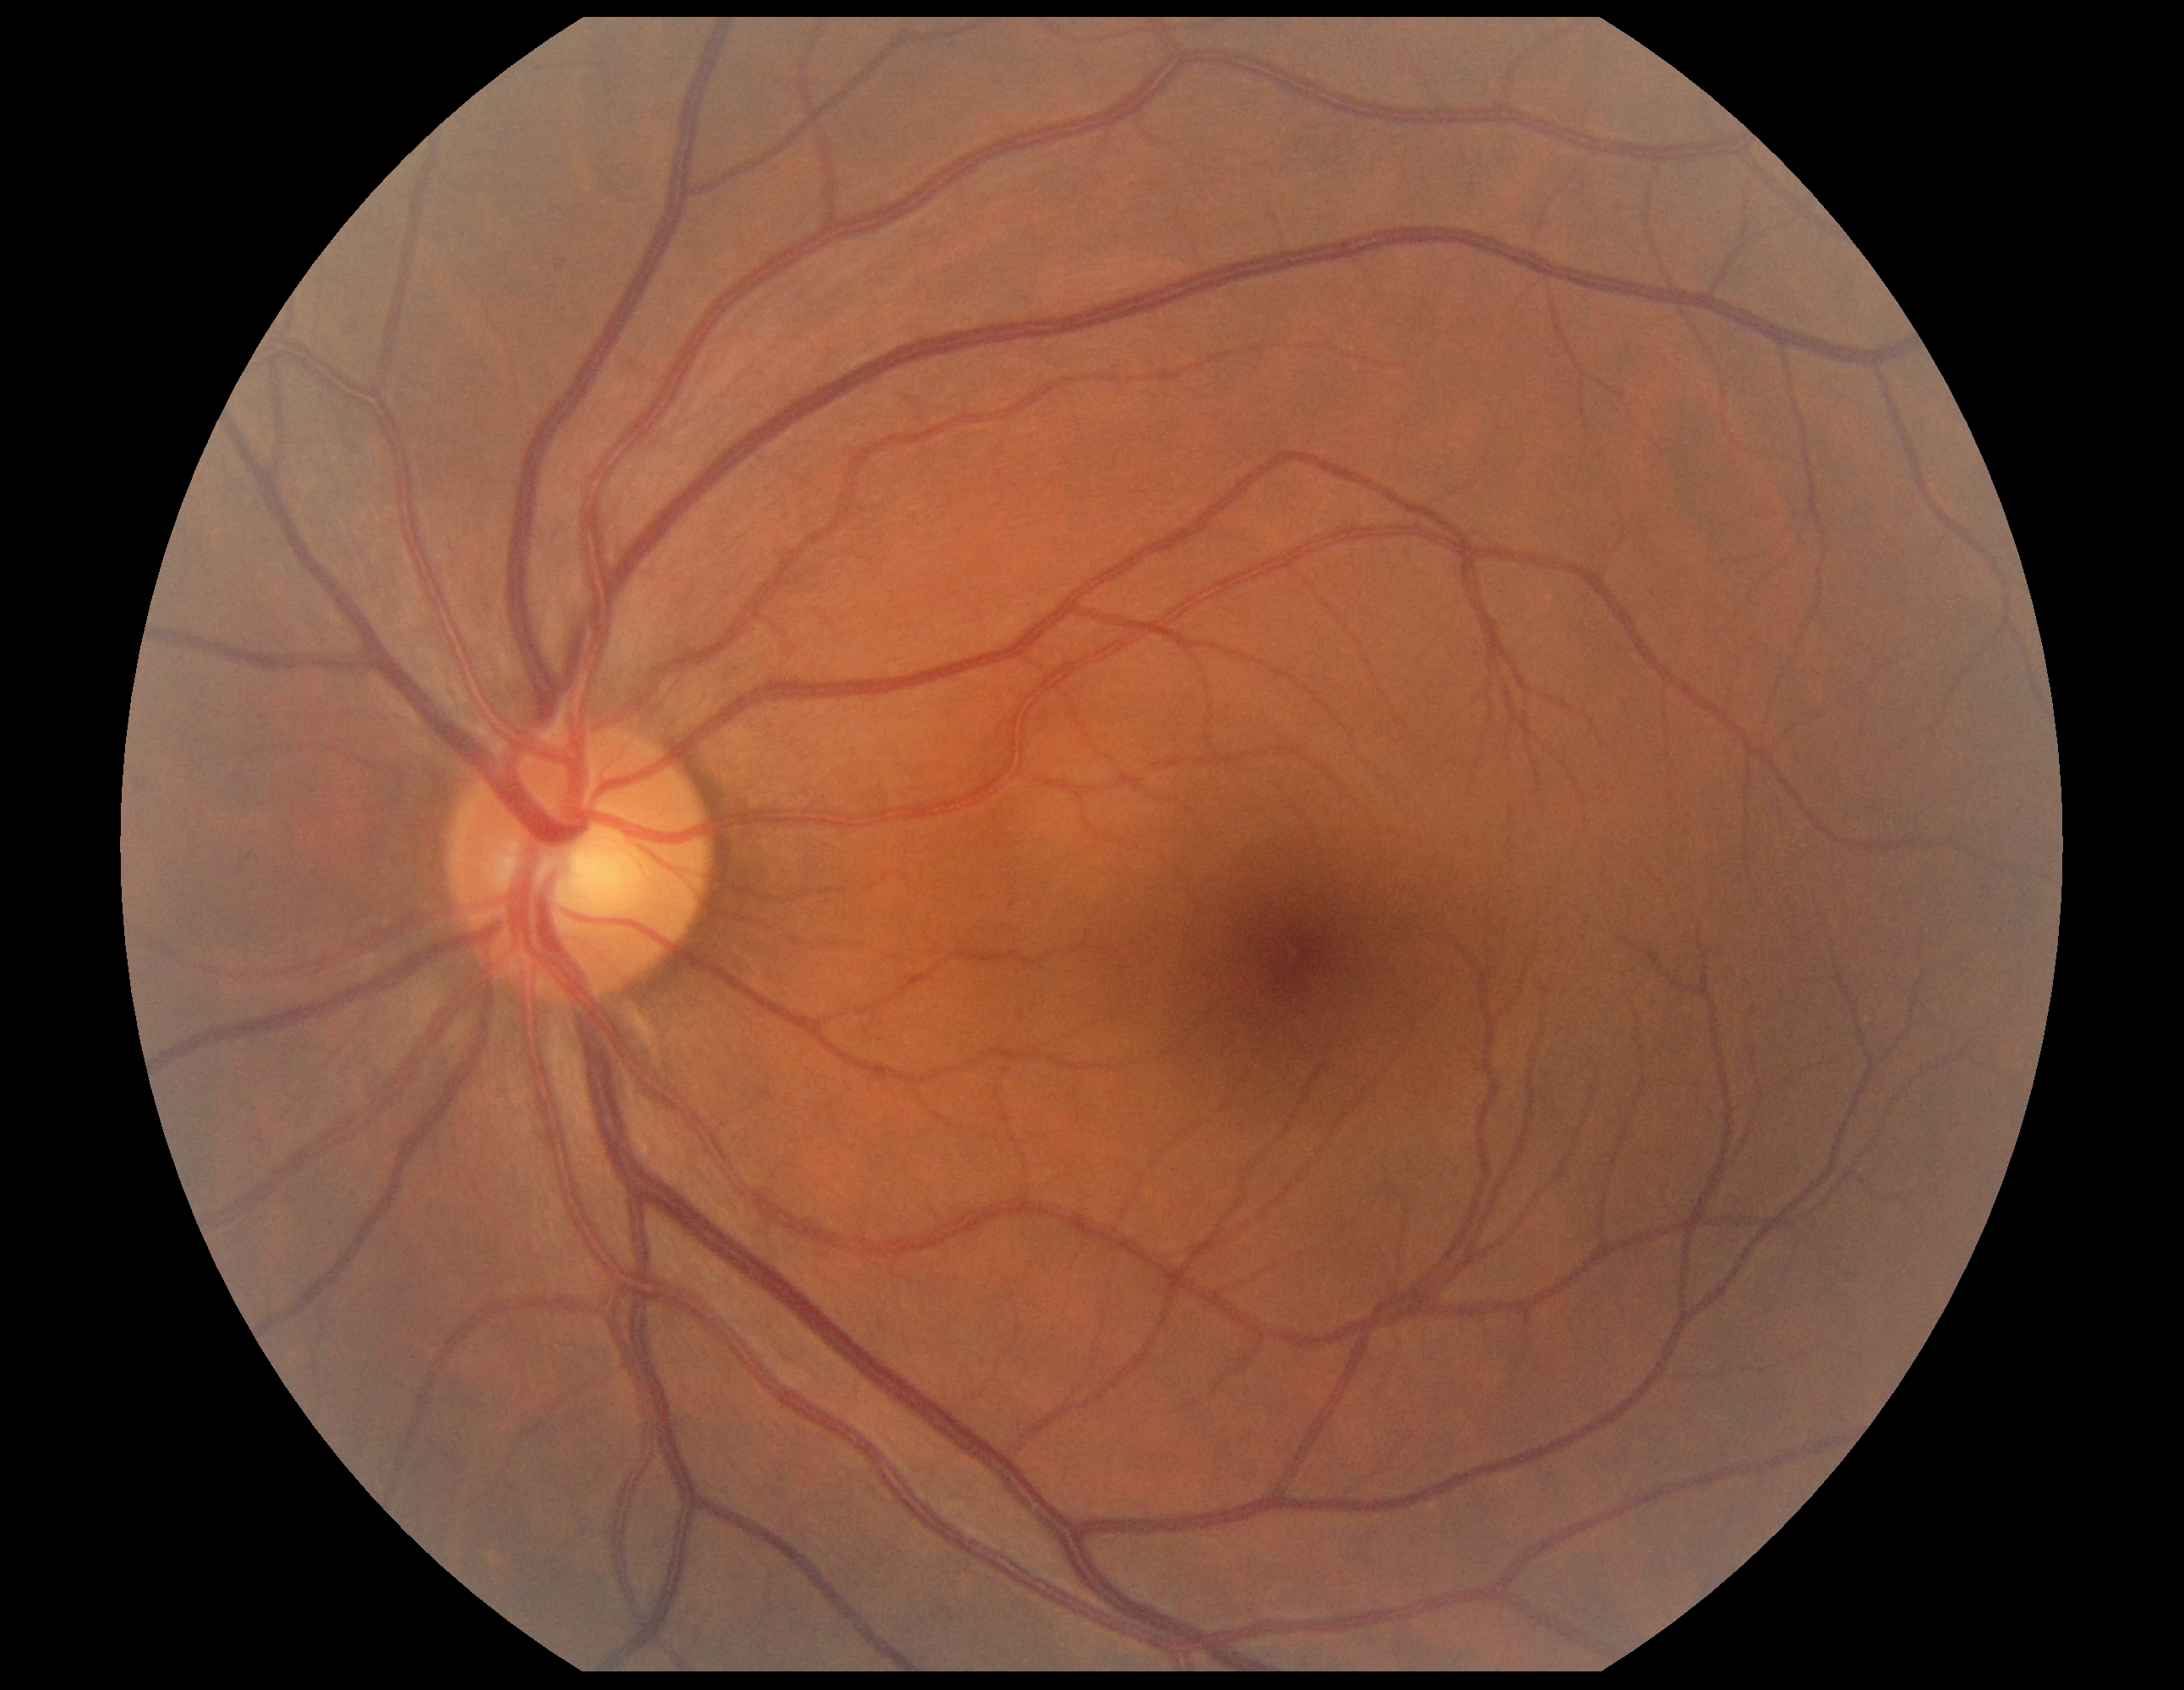
diabetic retinopathy = 0 — no visible signs of diabetic retinopathy.